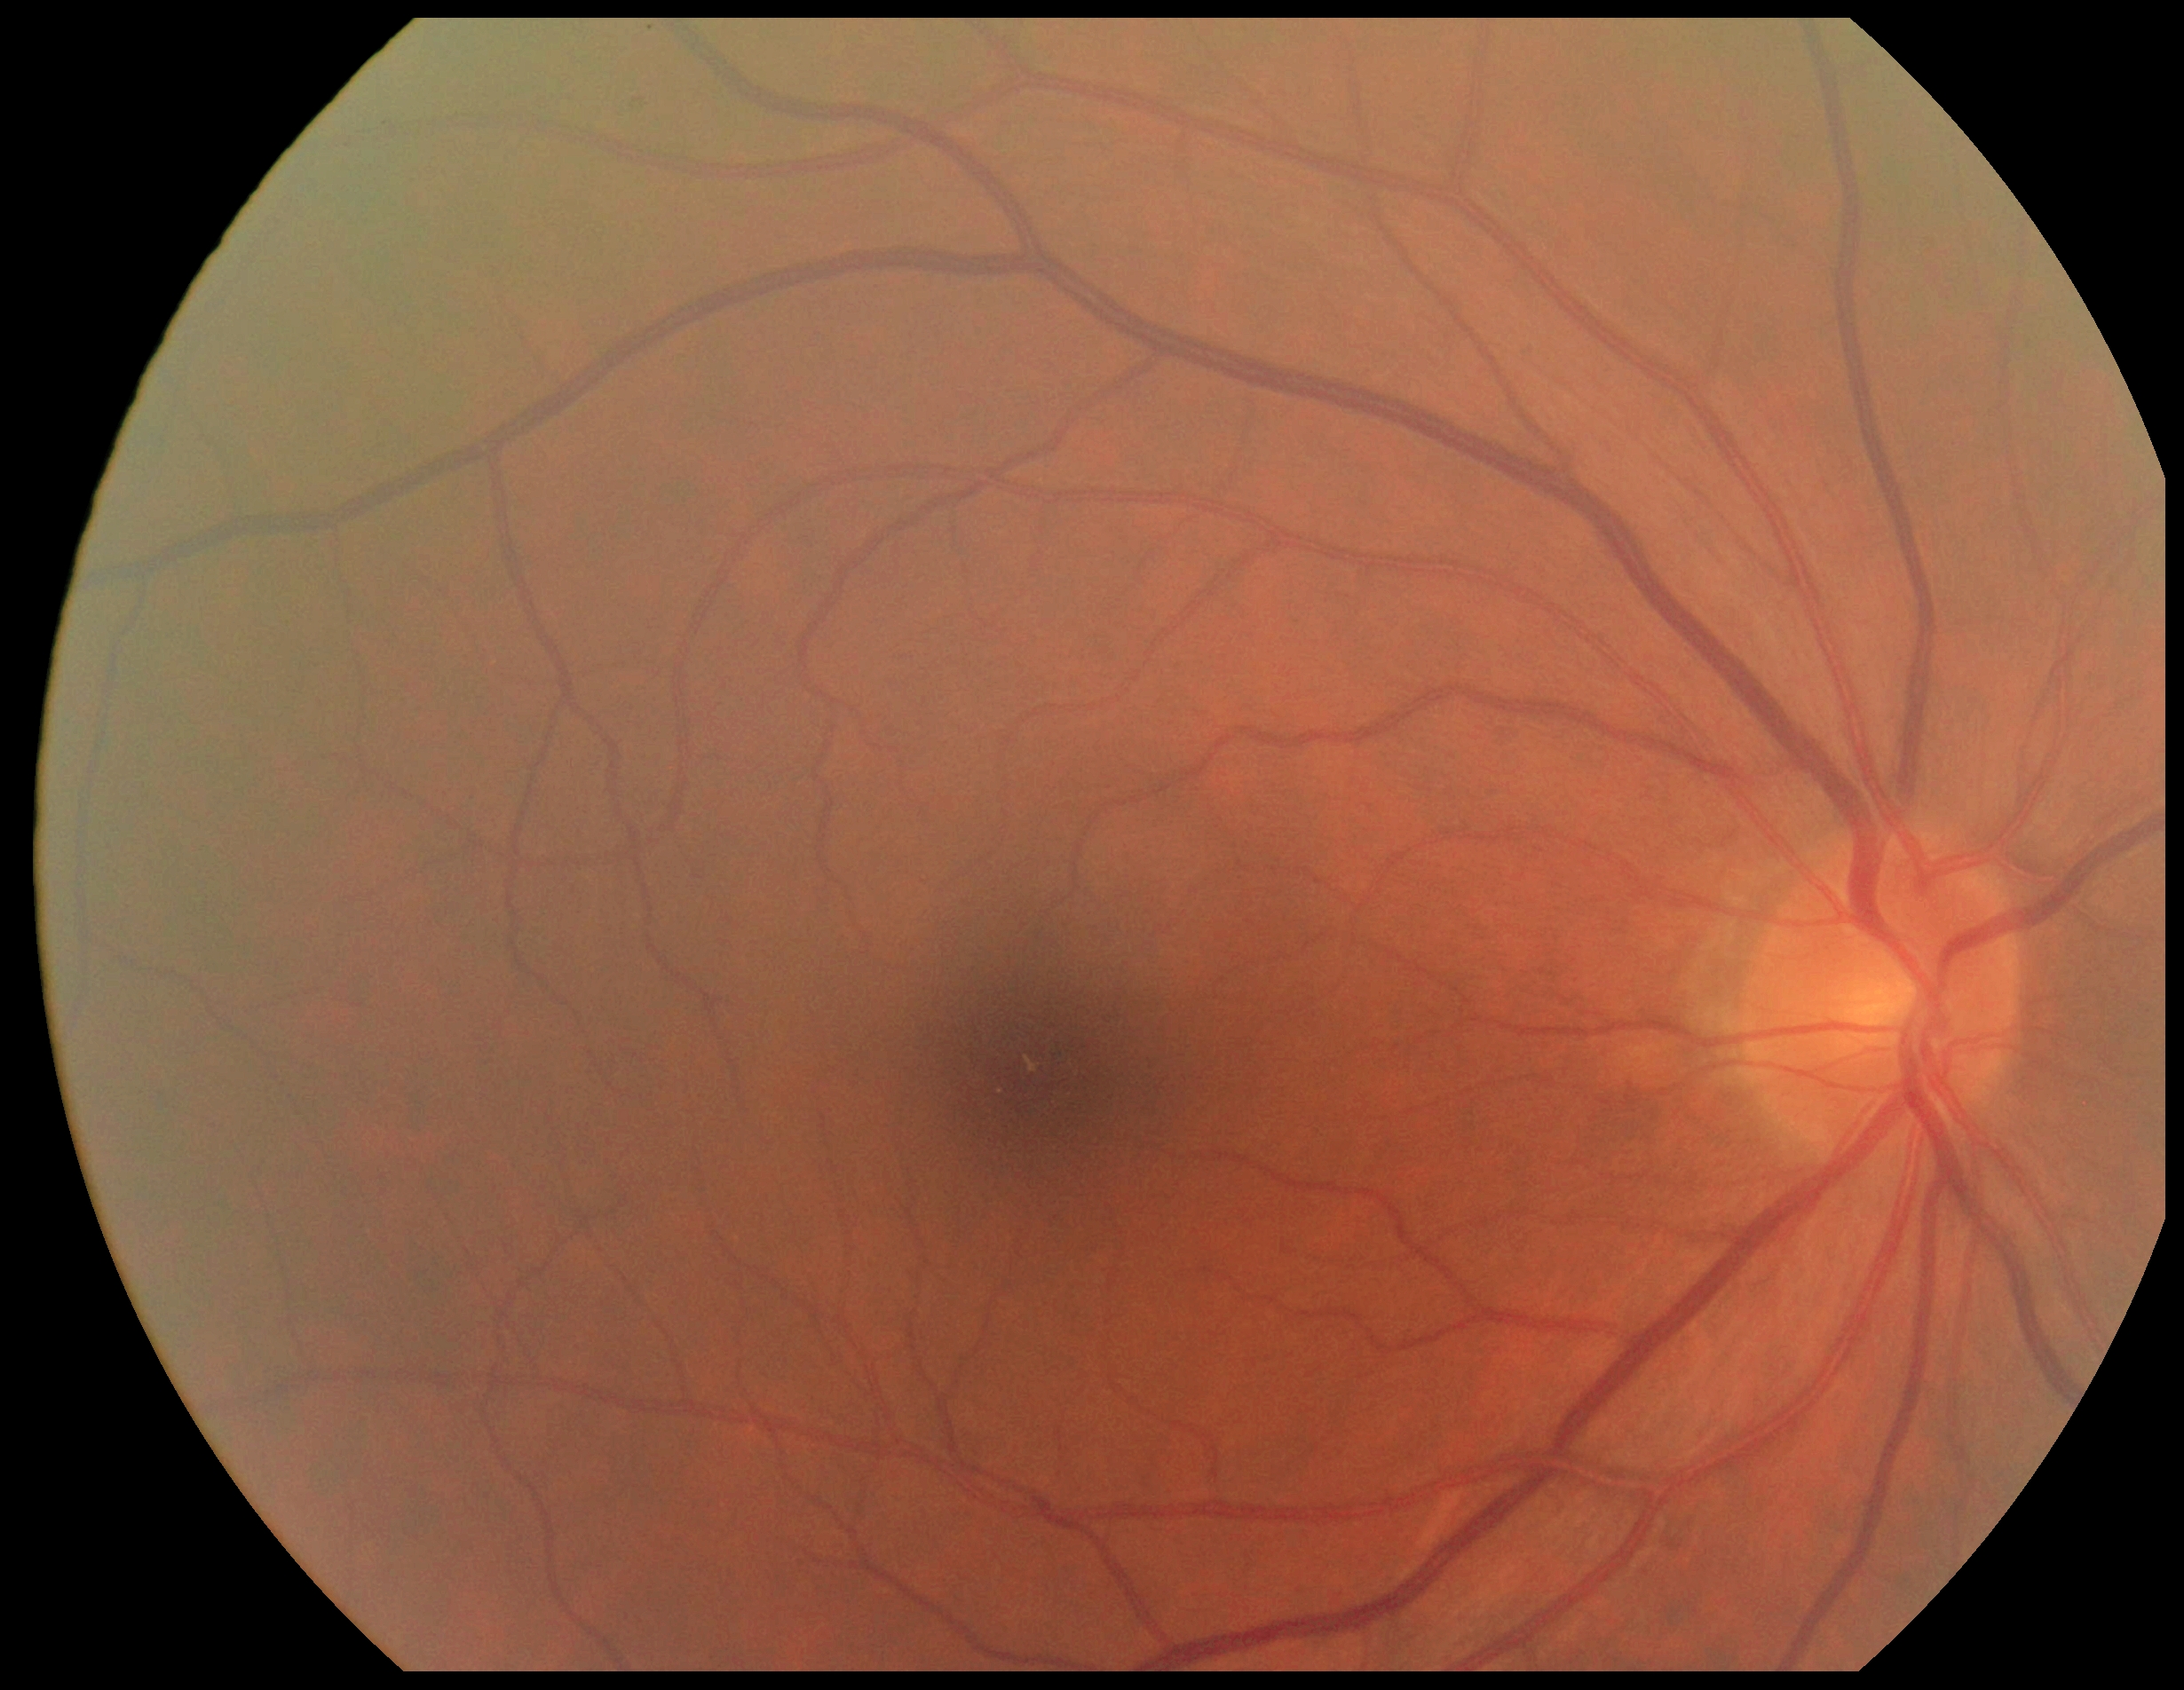 Findings:
- diabetic retinopathy (DR): grade 0